Wide-field fundus photograph from neonatal ROP screening; 1240x1240px: 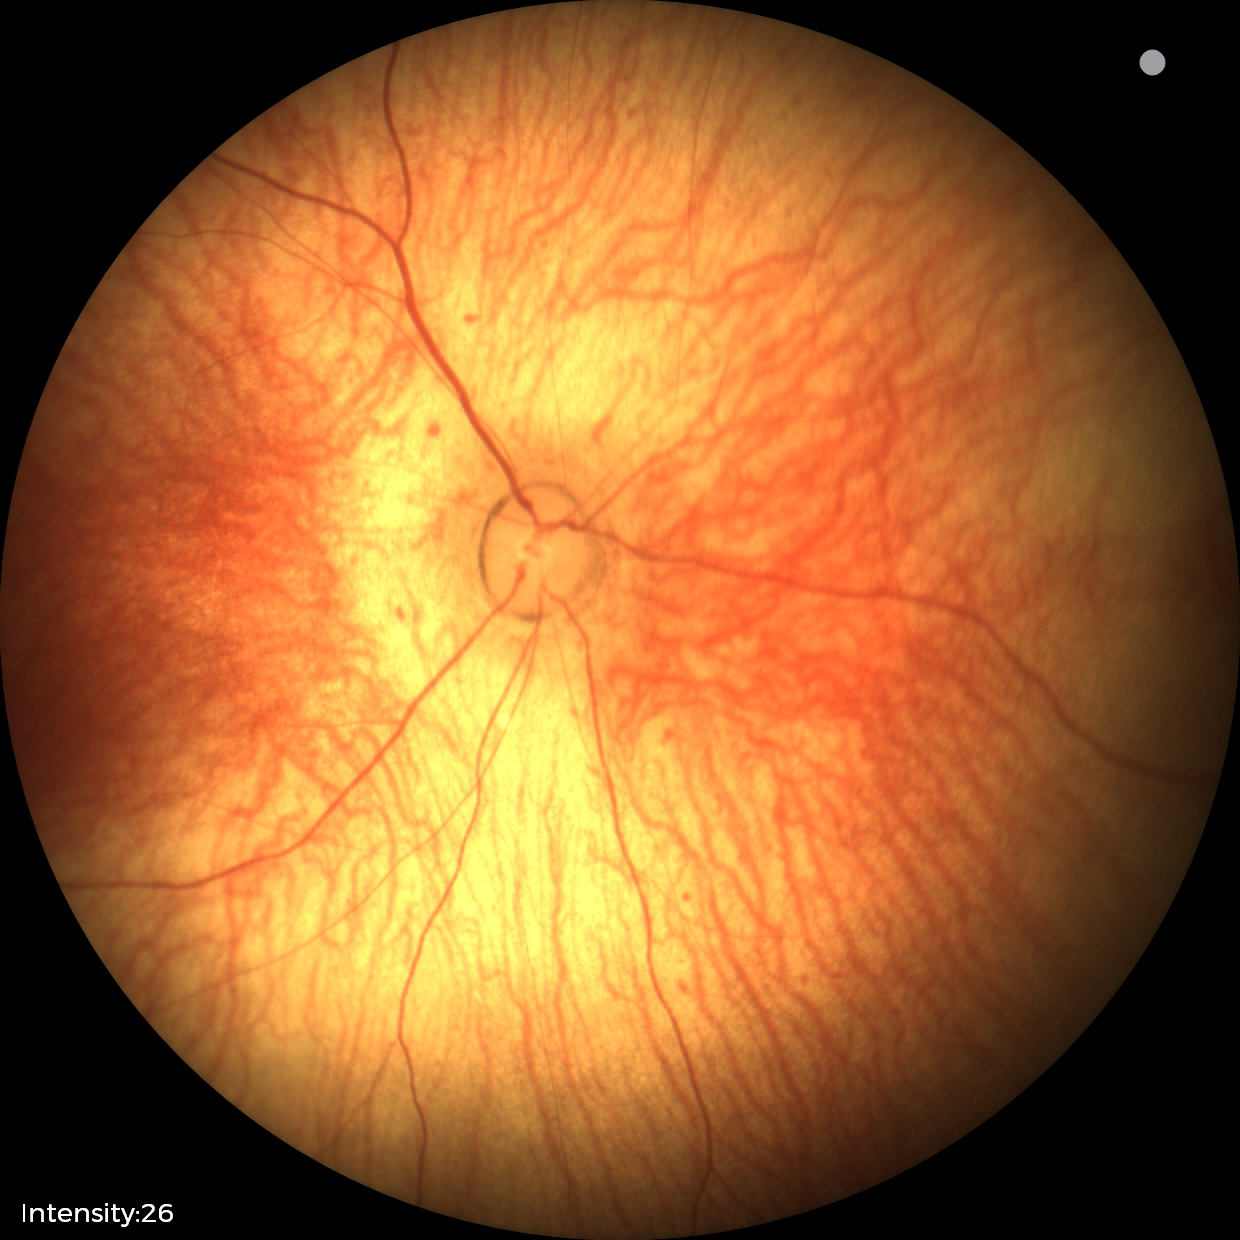

Screening examination with no abnormal retinal findings.